Without pupil dilation:
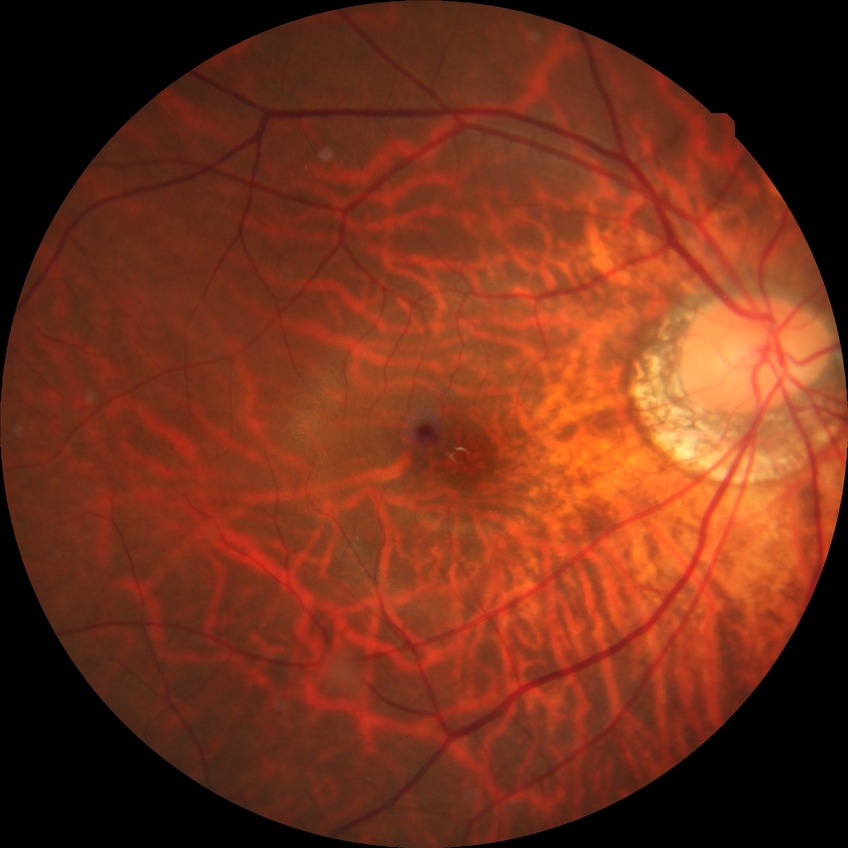 Davis grading: no diabetic retinopathy.